Color fundus image, 1659x2212.
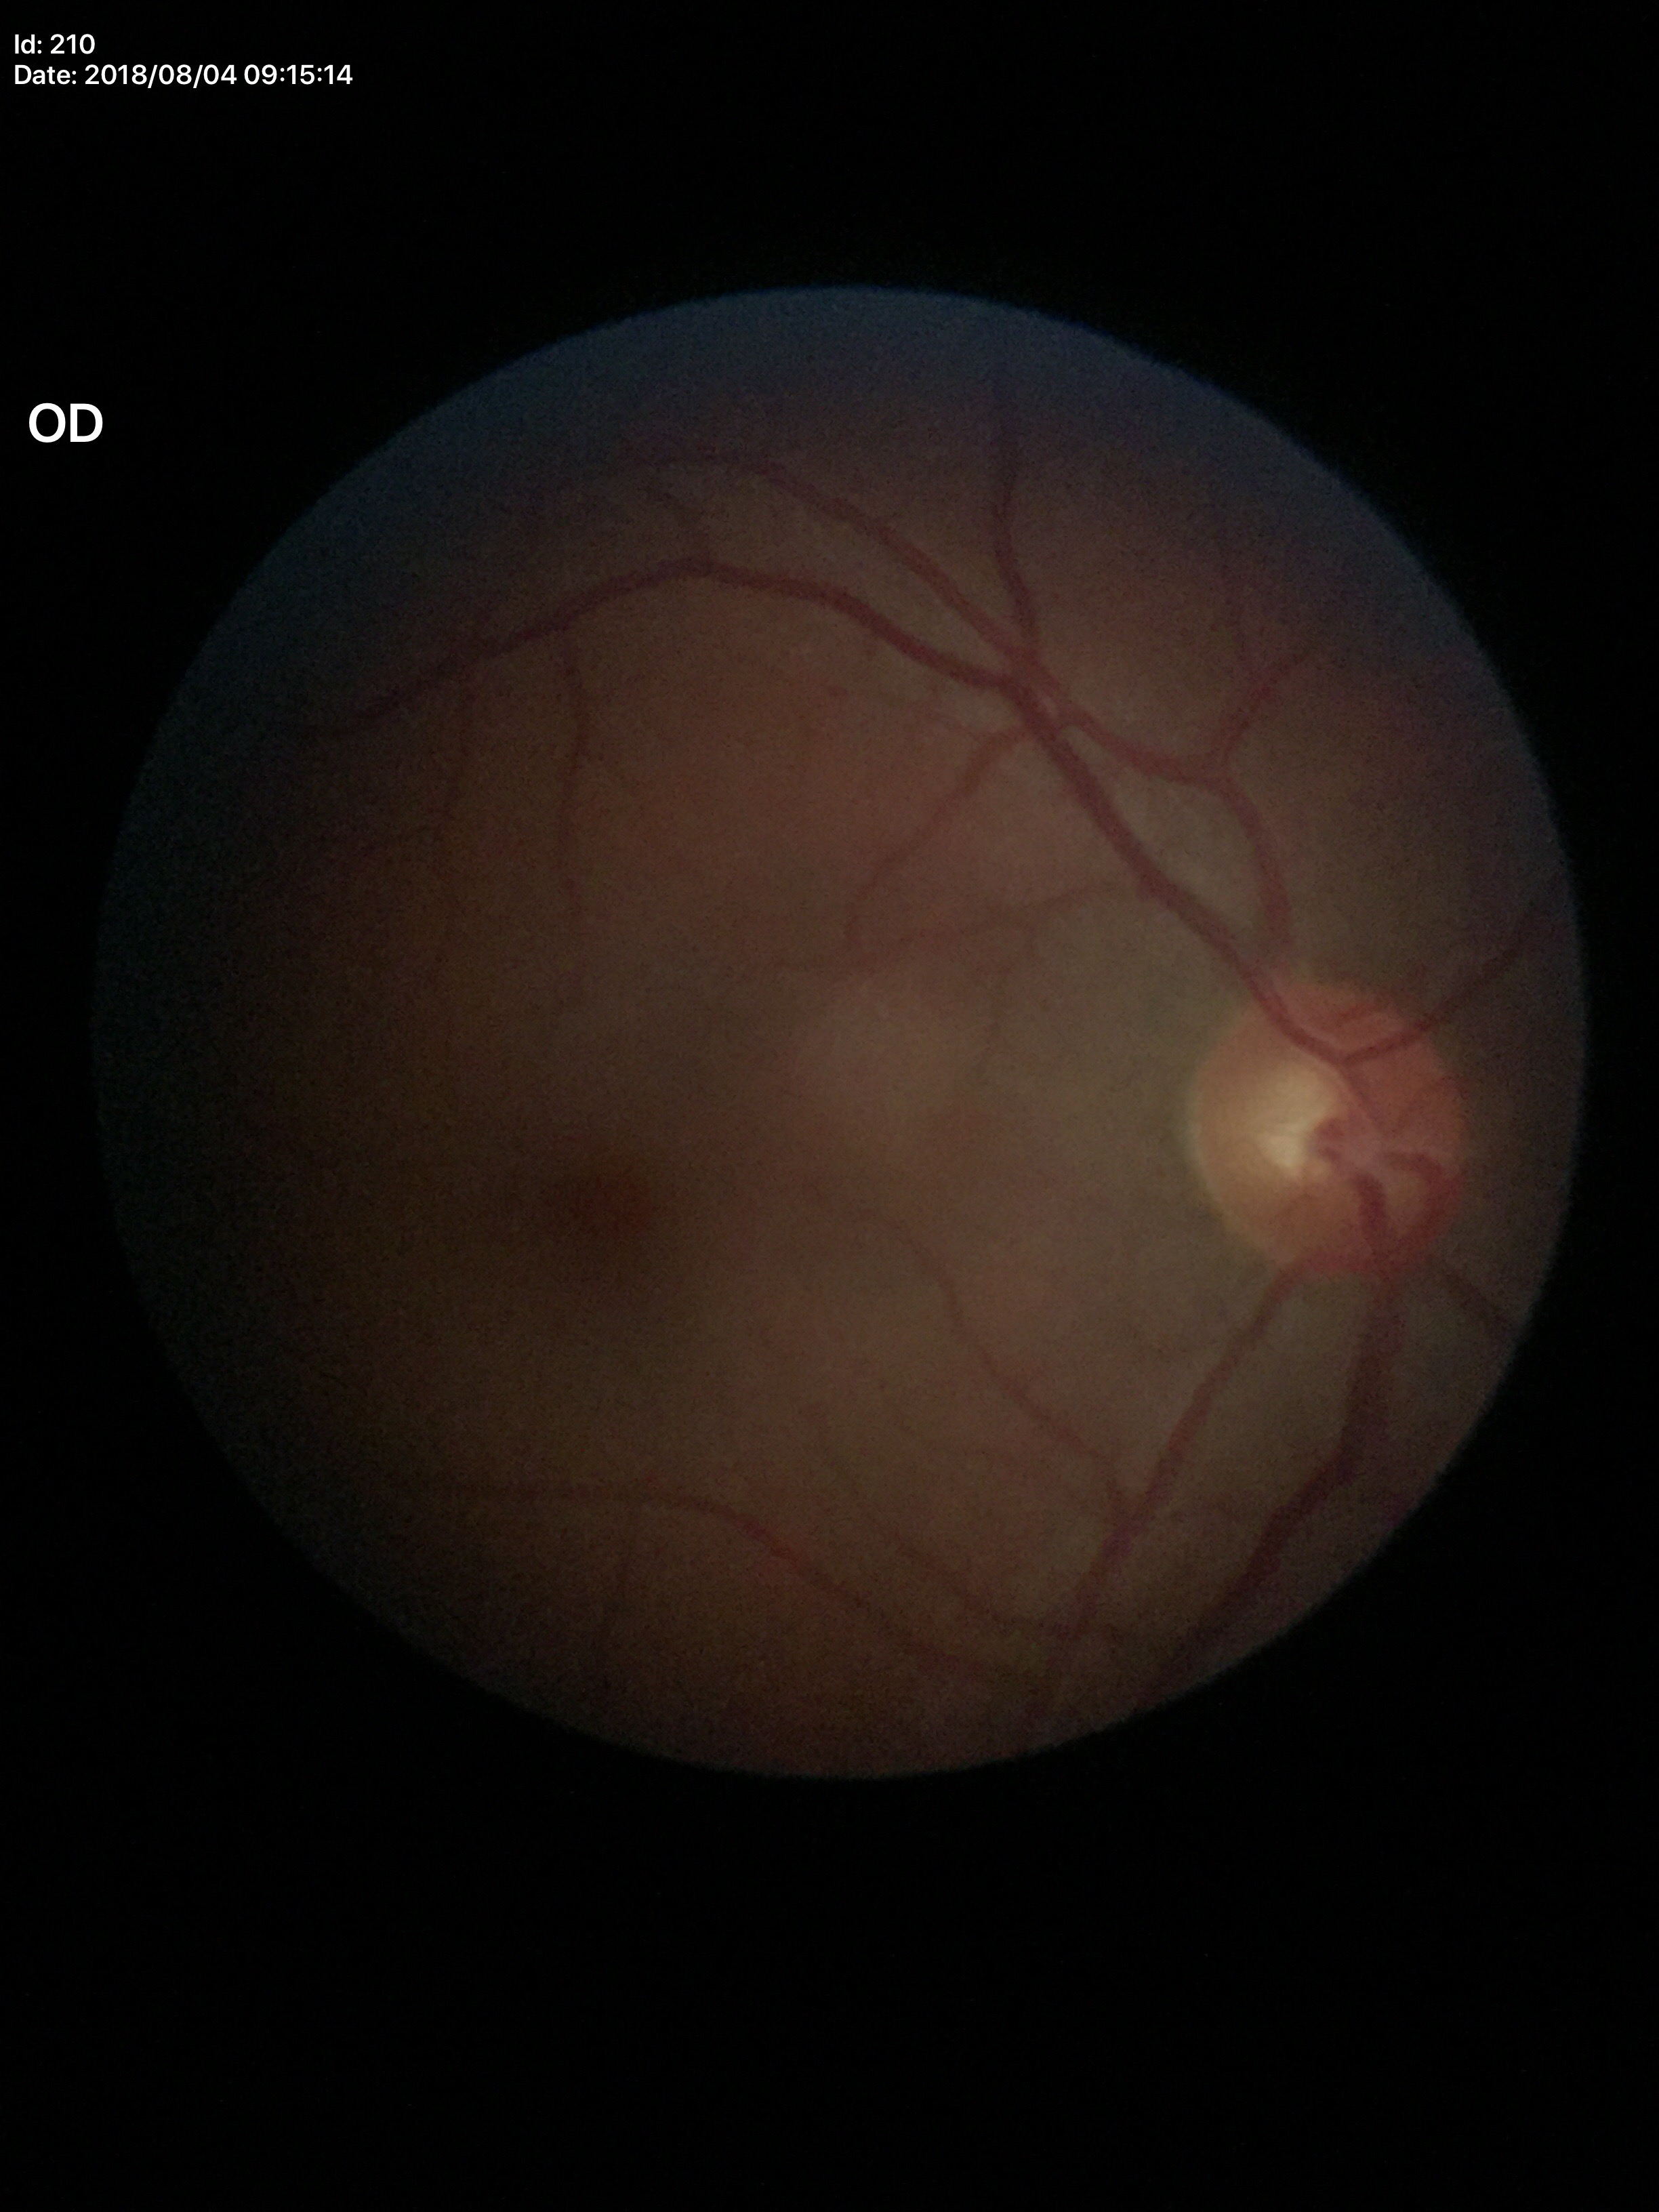
Glaucoma decision: no suspicious findings.
Vertical CDR of 0.43.